35° field of view before cropping · color fundus photograph centered on the optic disc.
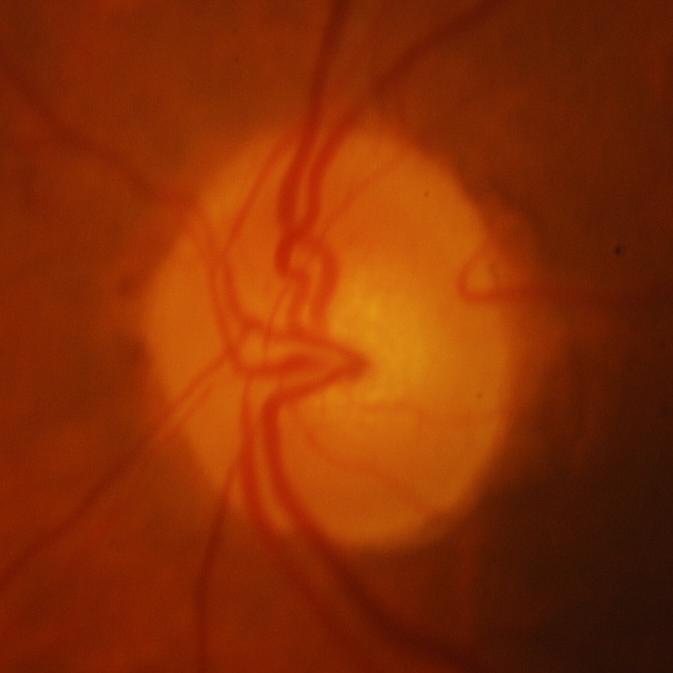 Glaucoma is present. Consistent with glaucomatous optic neuropathy.